Acquired on the Phoenix ICON · infant wide-field fundus photograph · 1240 by 1240 pixels — 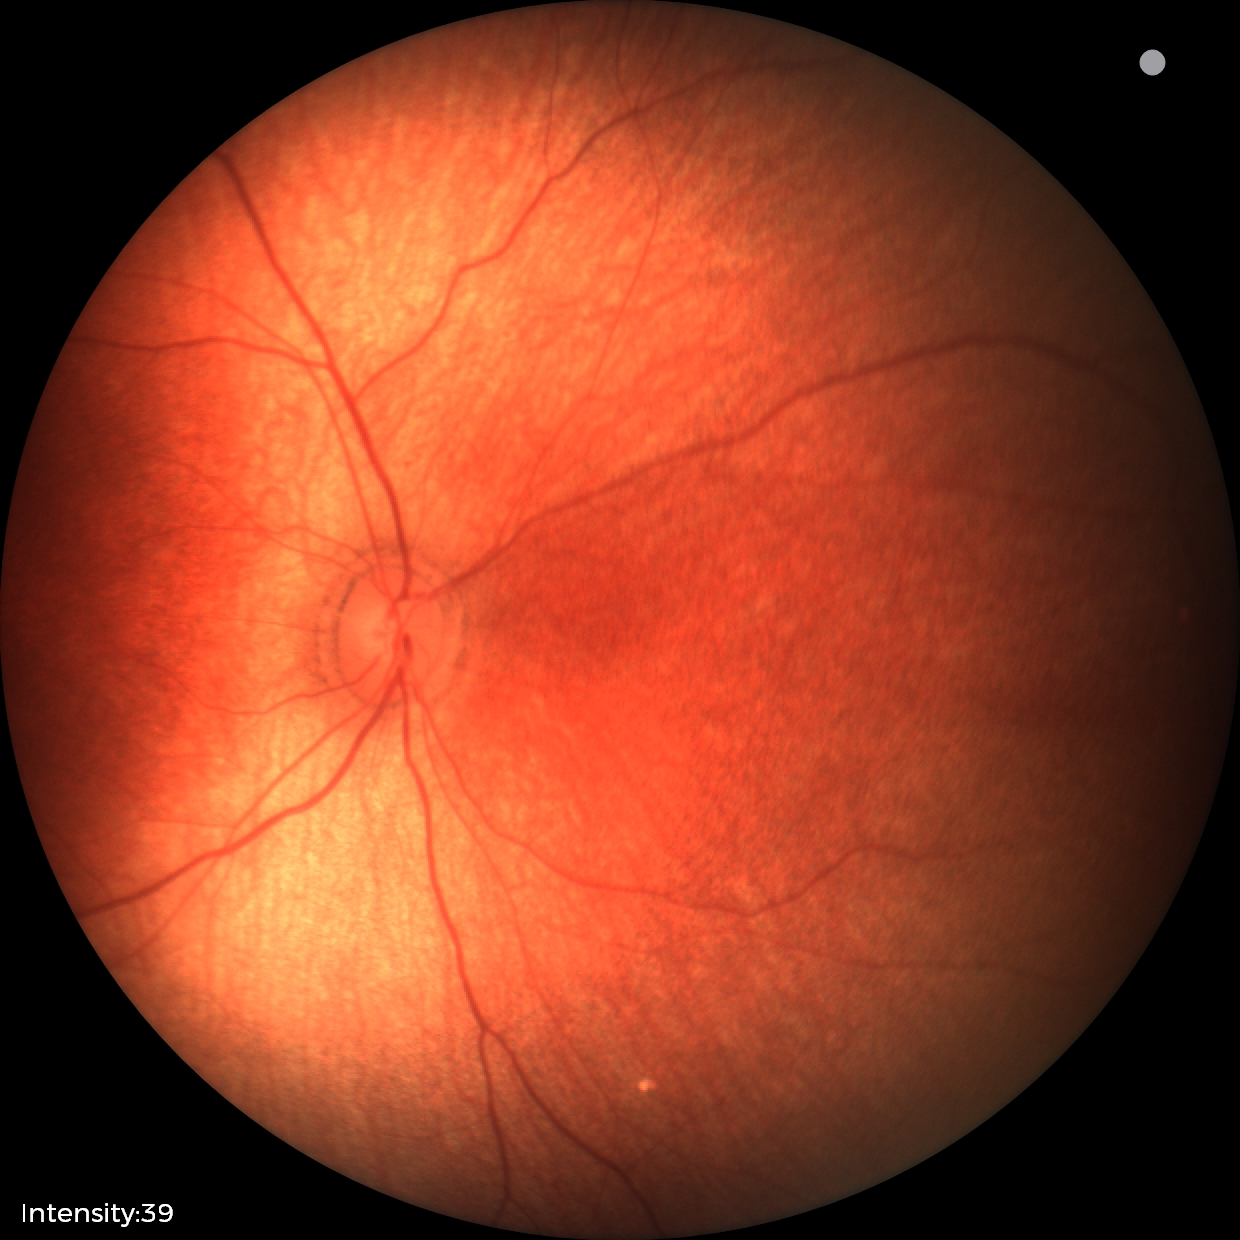
Physiological retinal appearance for postconceptual age.